CFP, 45-degree field of view, 1932x1916px: 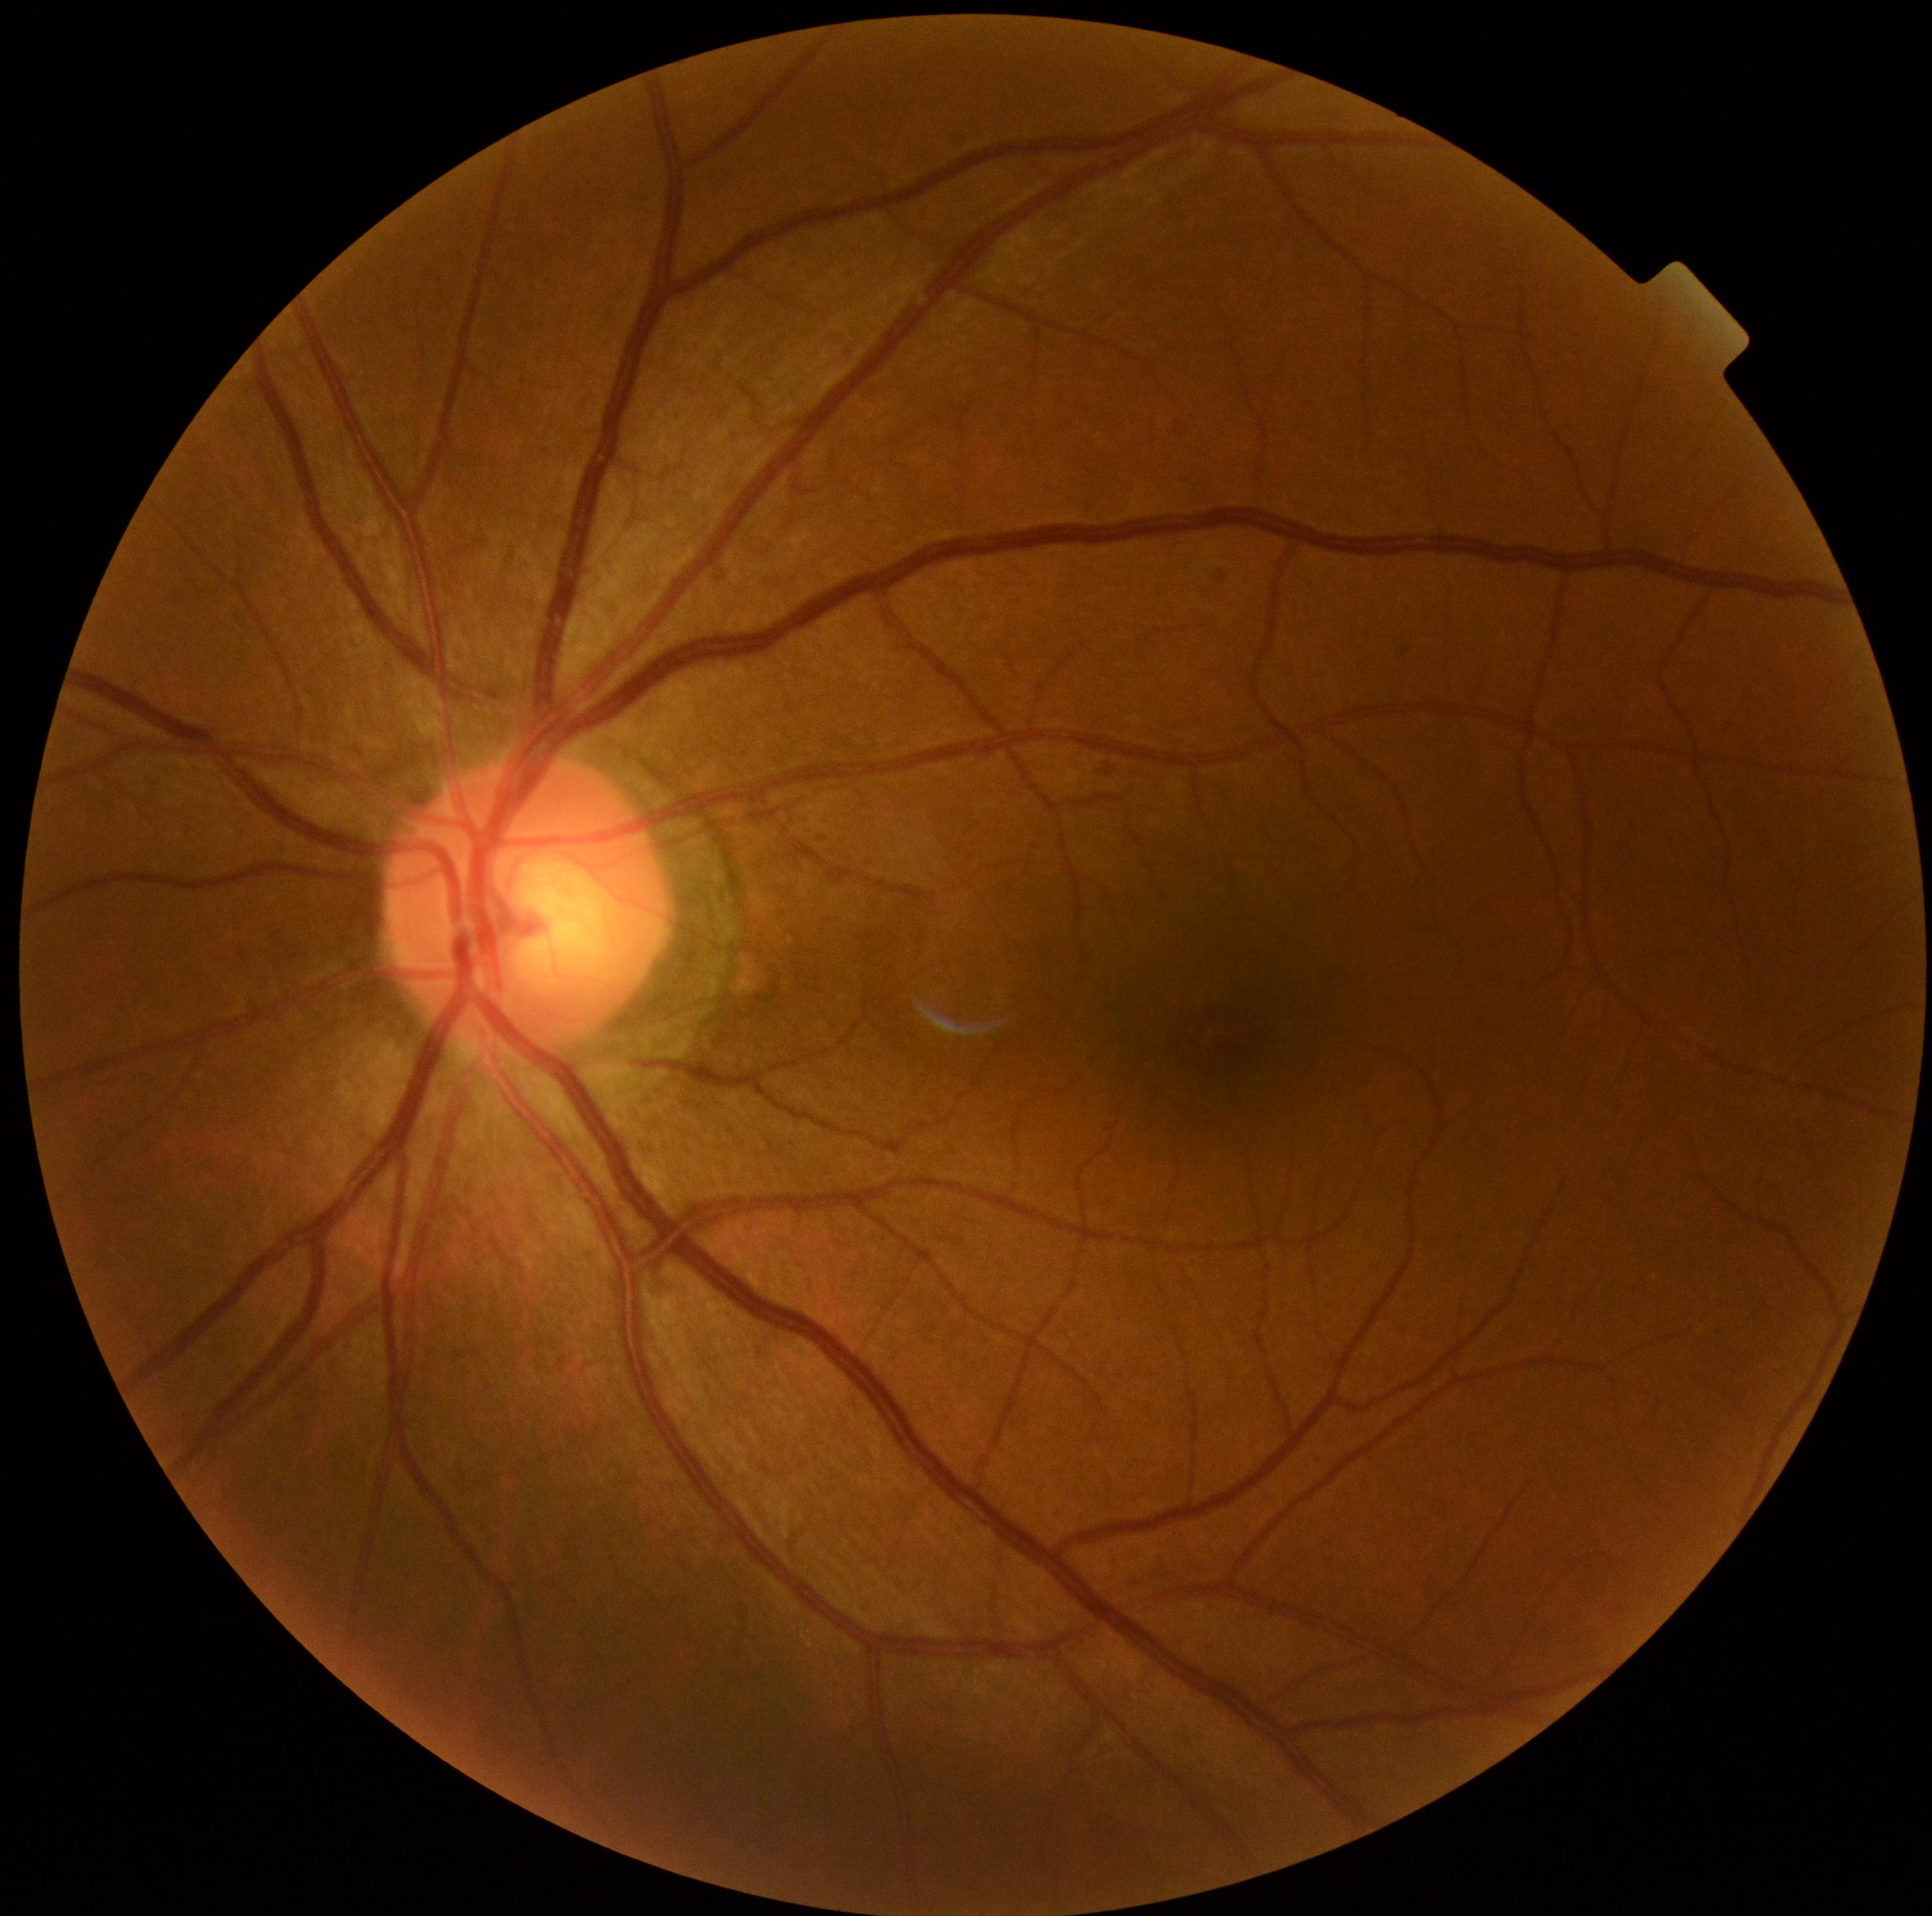
DR severity is 0 — no visible signs of diabetic retinopathy.